Wide-field fundus photograph from neonatal ROP screening
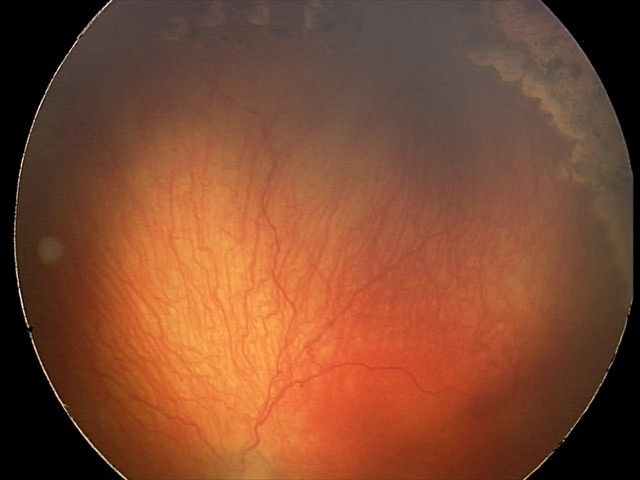 Diagnosis from this screening exam: A-ROP (aggressive ROP).
With plus disease.